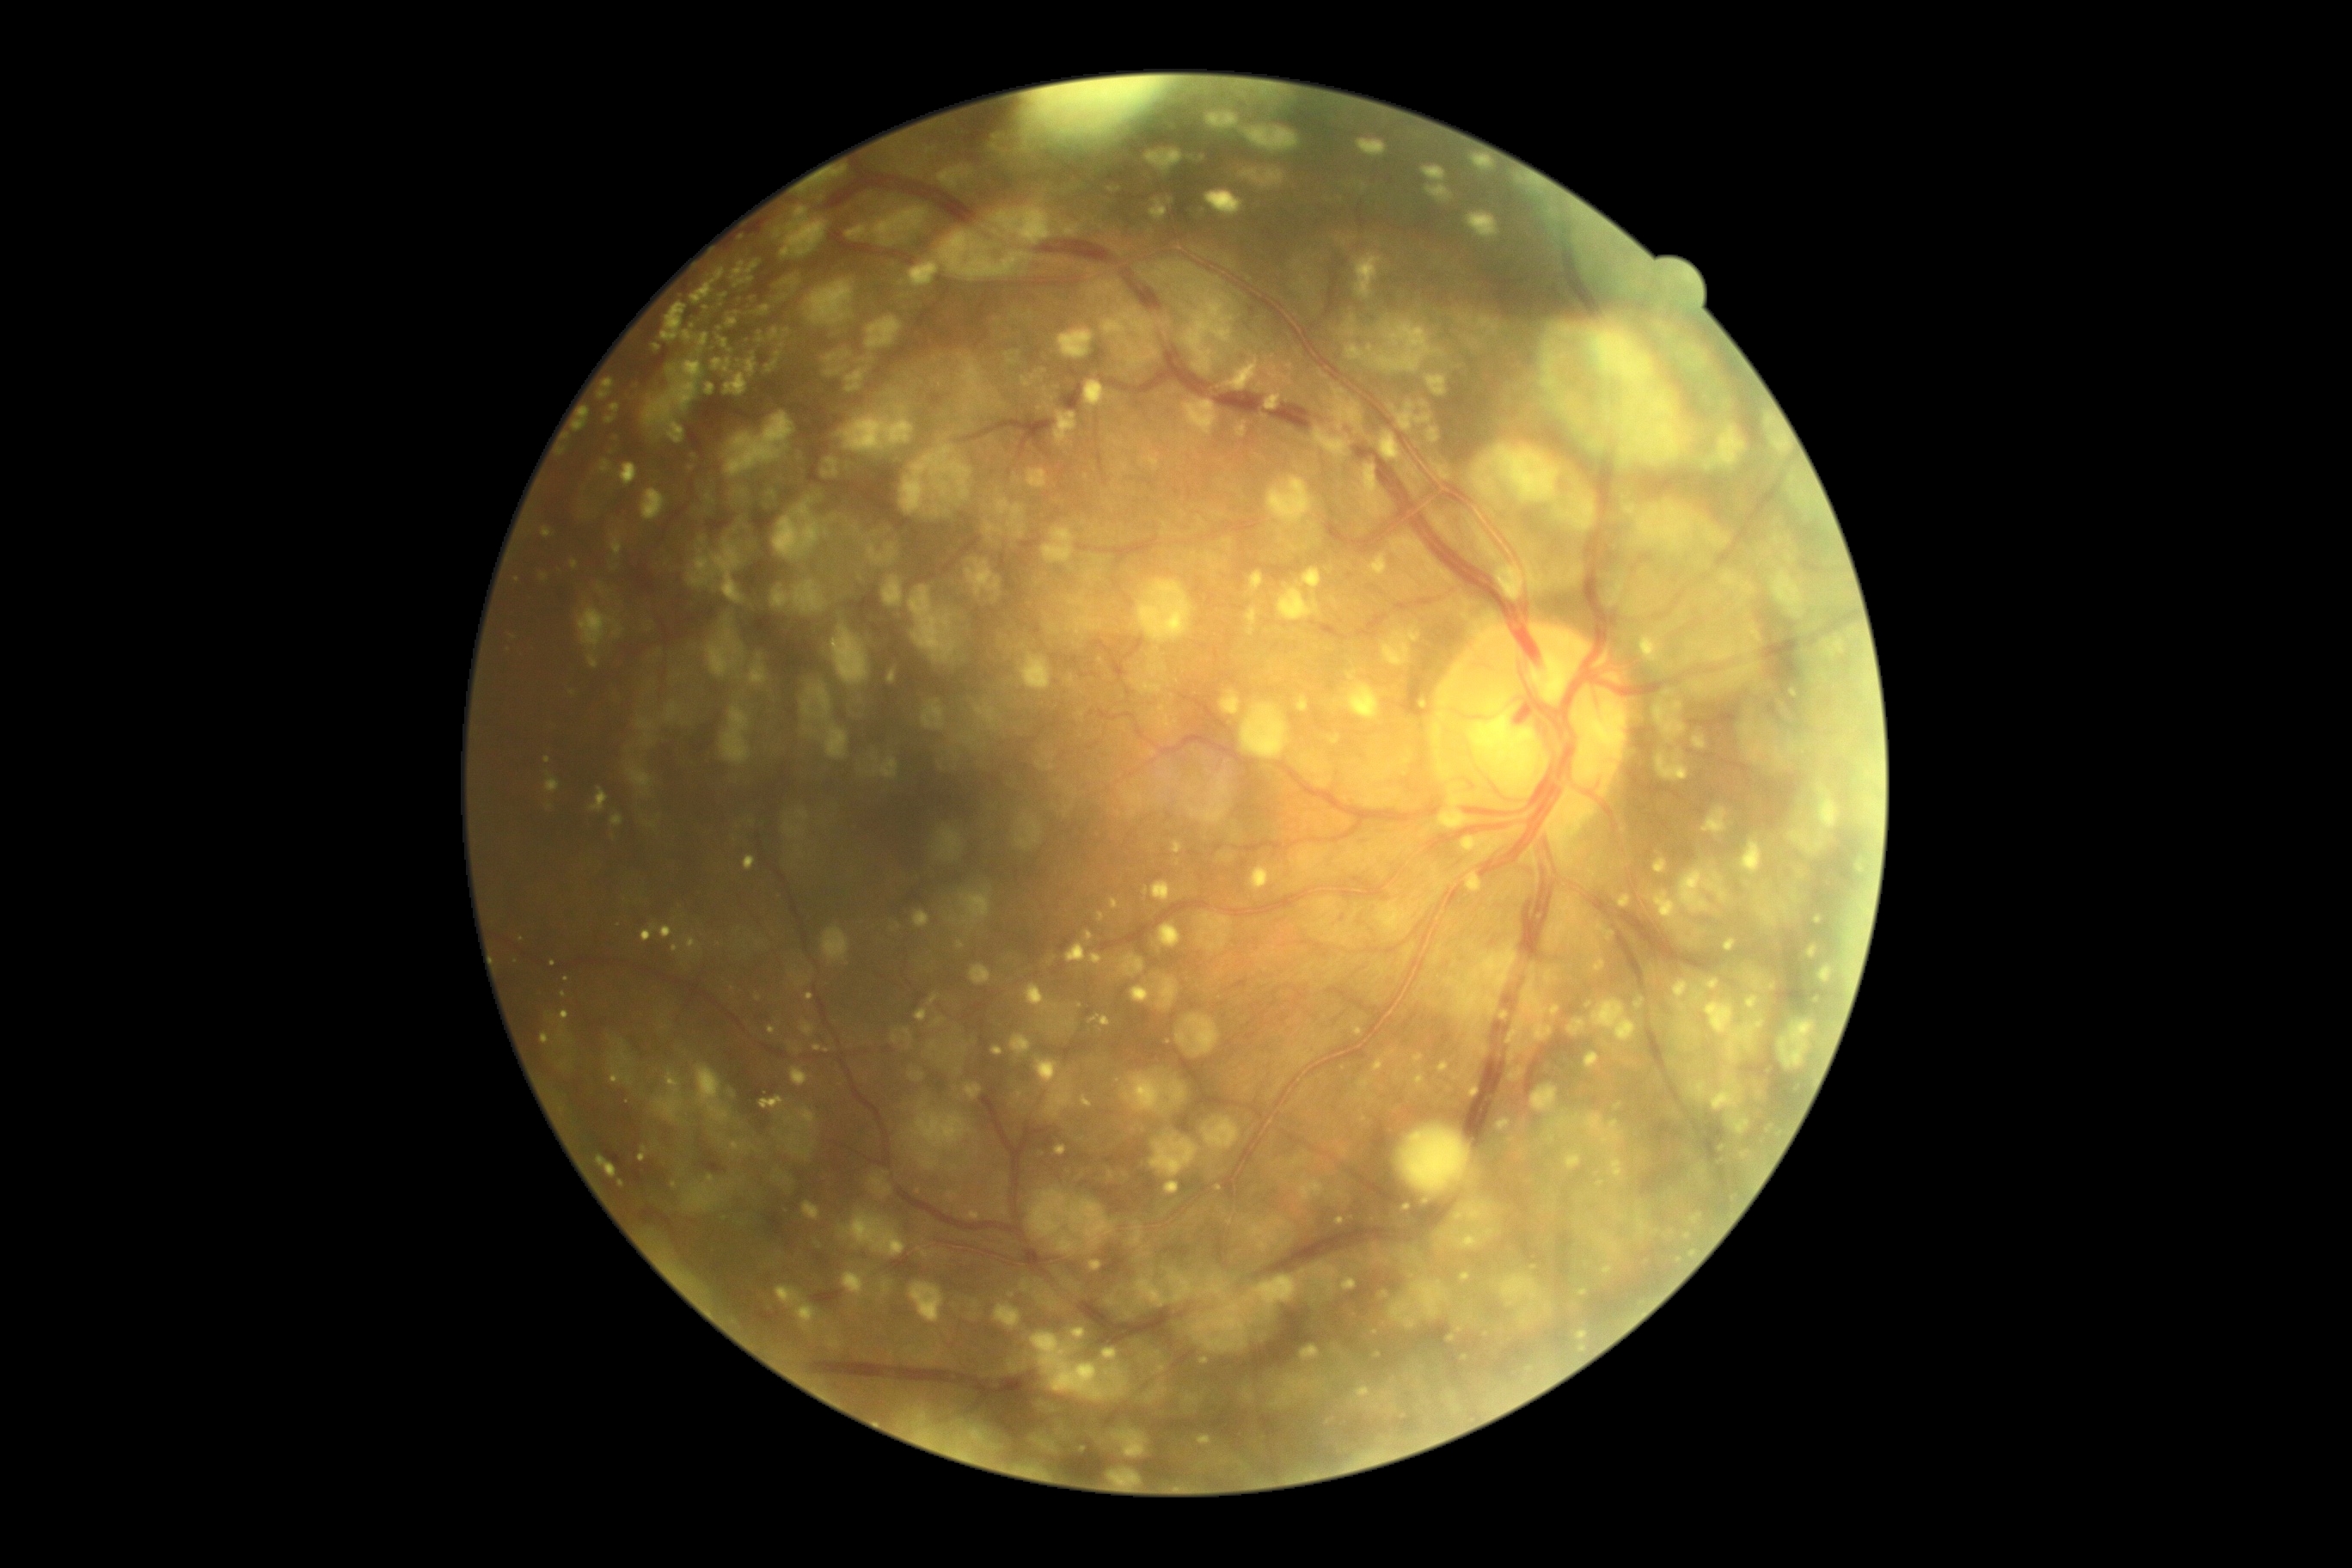 Diabetic retinopathy grade: 1/4 — presence of microaneurysms only.